640x480 · camera: Clarity RetCam 3 (130° FOV) · RetCam wide-field infant fundus image:
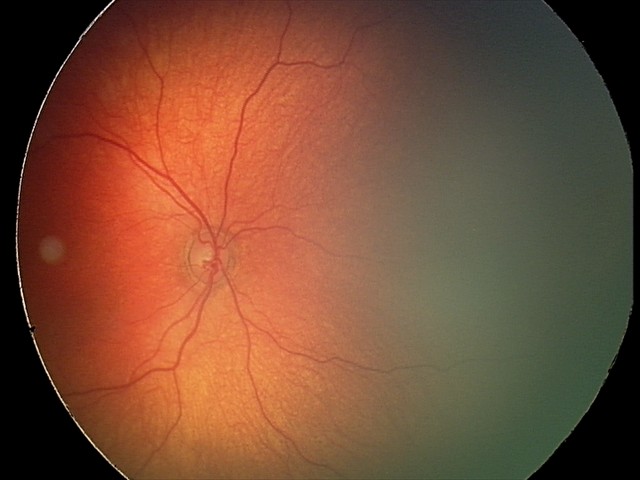

Q: What is the screening diagnosis?
A: physiological finding